Wide-field retinal mosaic image: 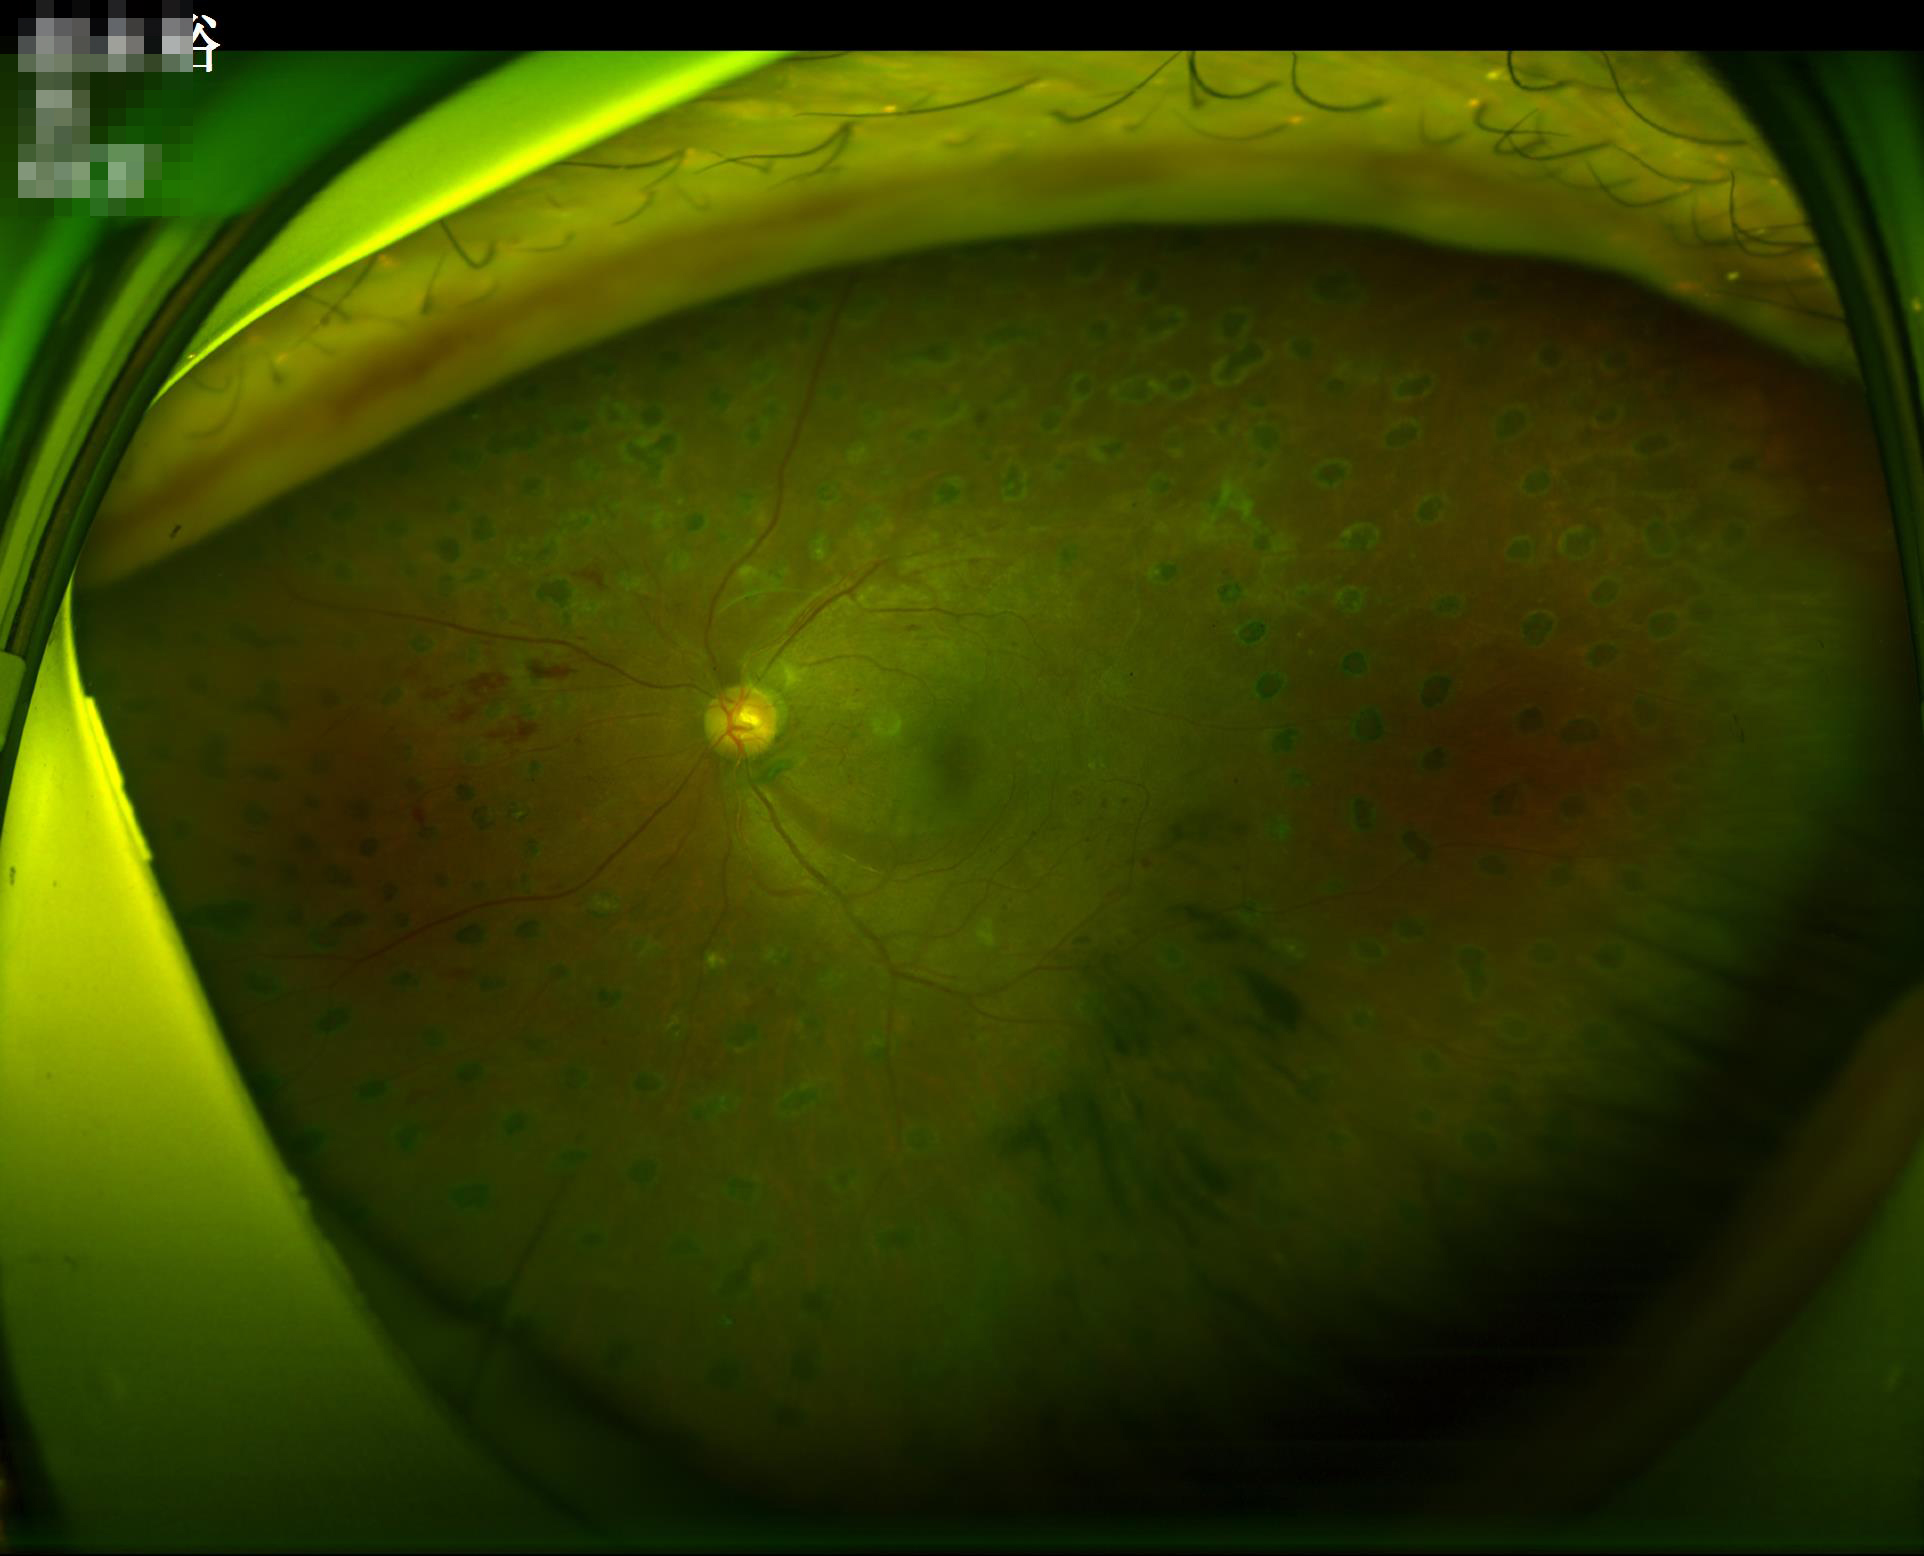

Illumination/color: over- or under-exposed; Contrast: vessels and details readily distinguishable; Overall: good and suitable for diagnostic use.